Macula at the center of the field; pupil-dilated; 50-degree field of view: 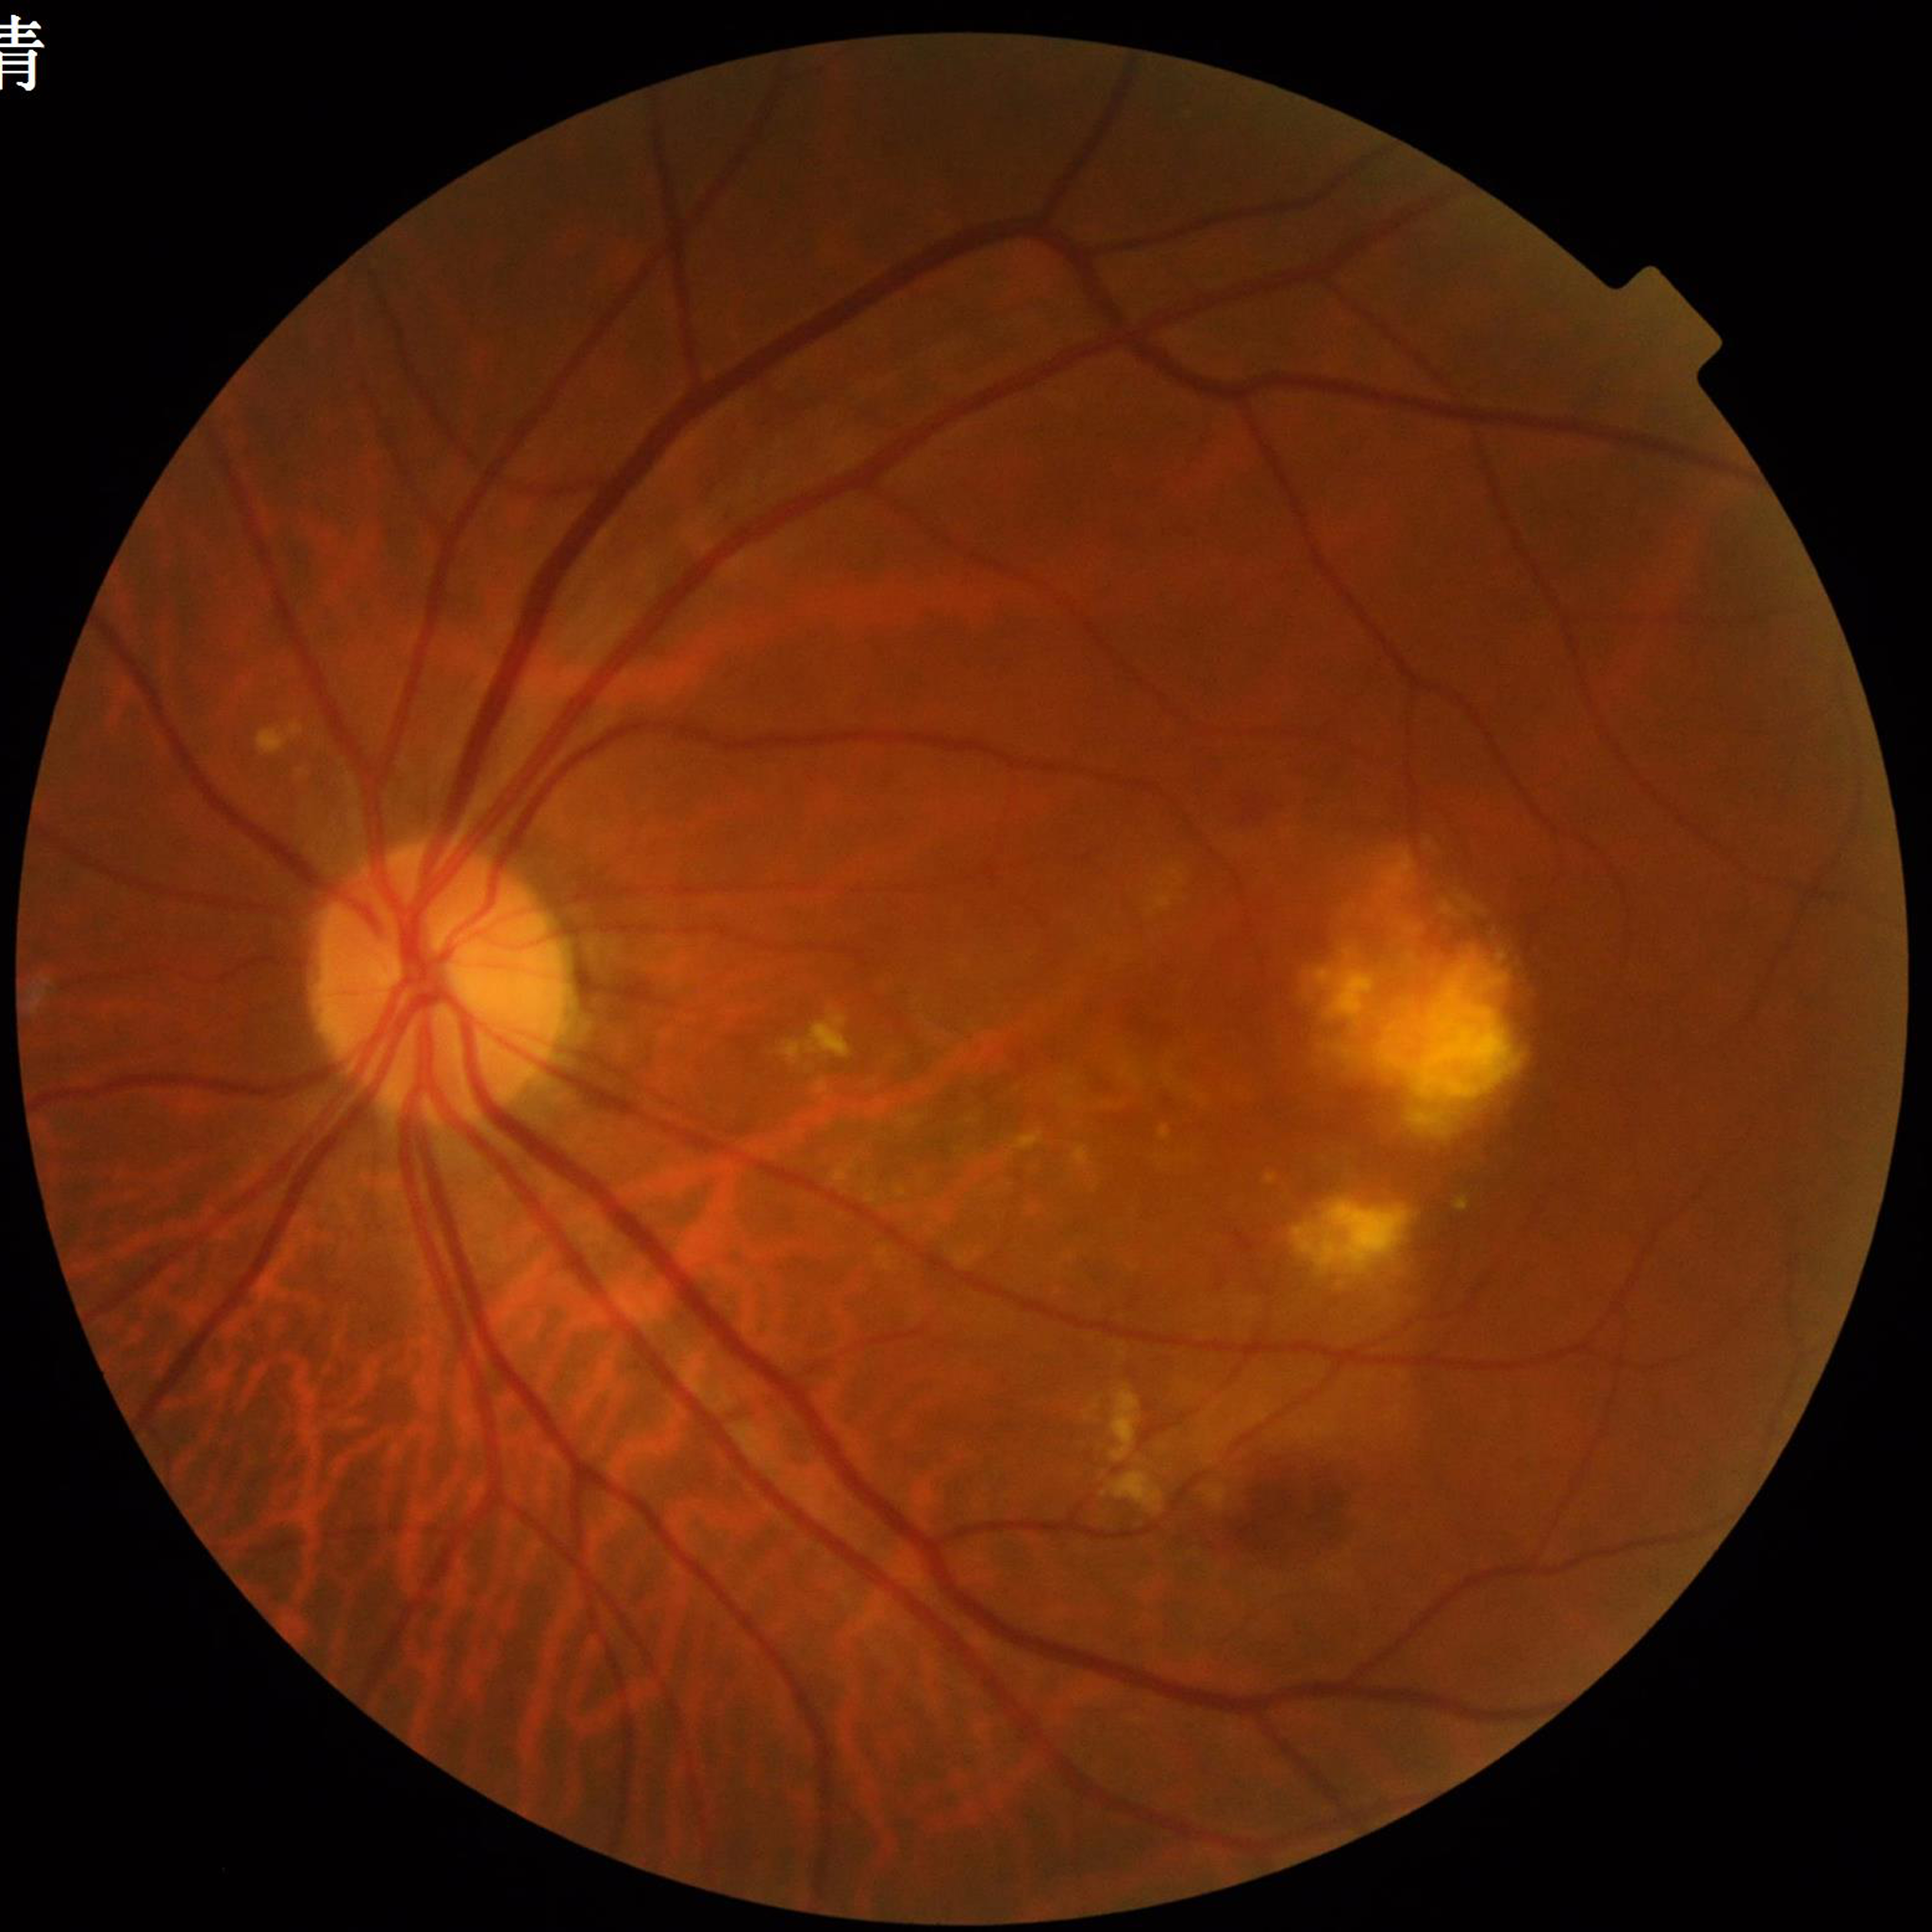
diagnosis: age-related macular degeneration (AMD)
image_quality: no quality issues identified